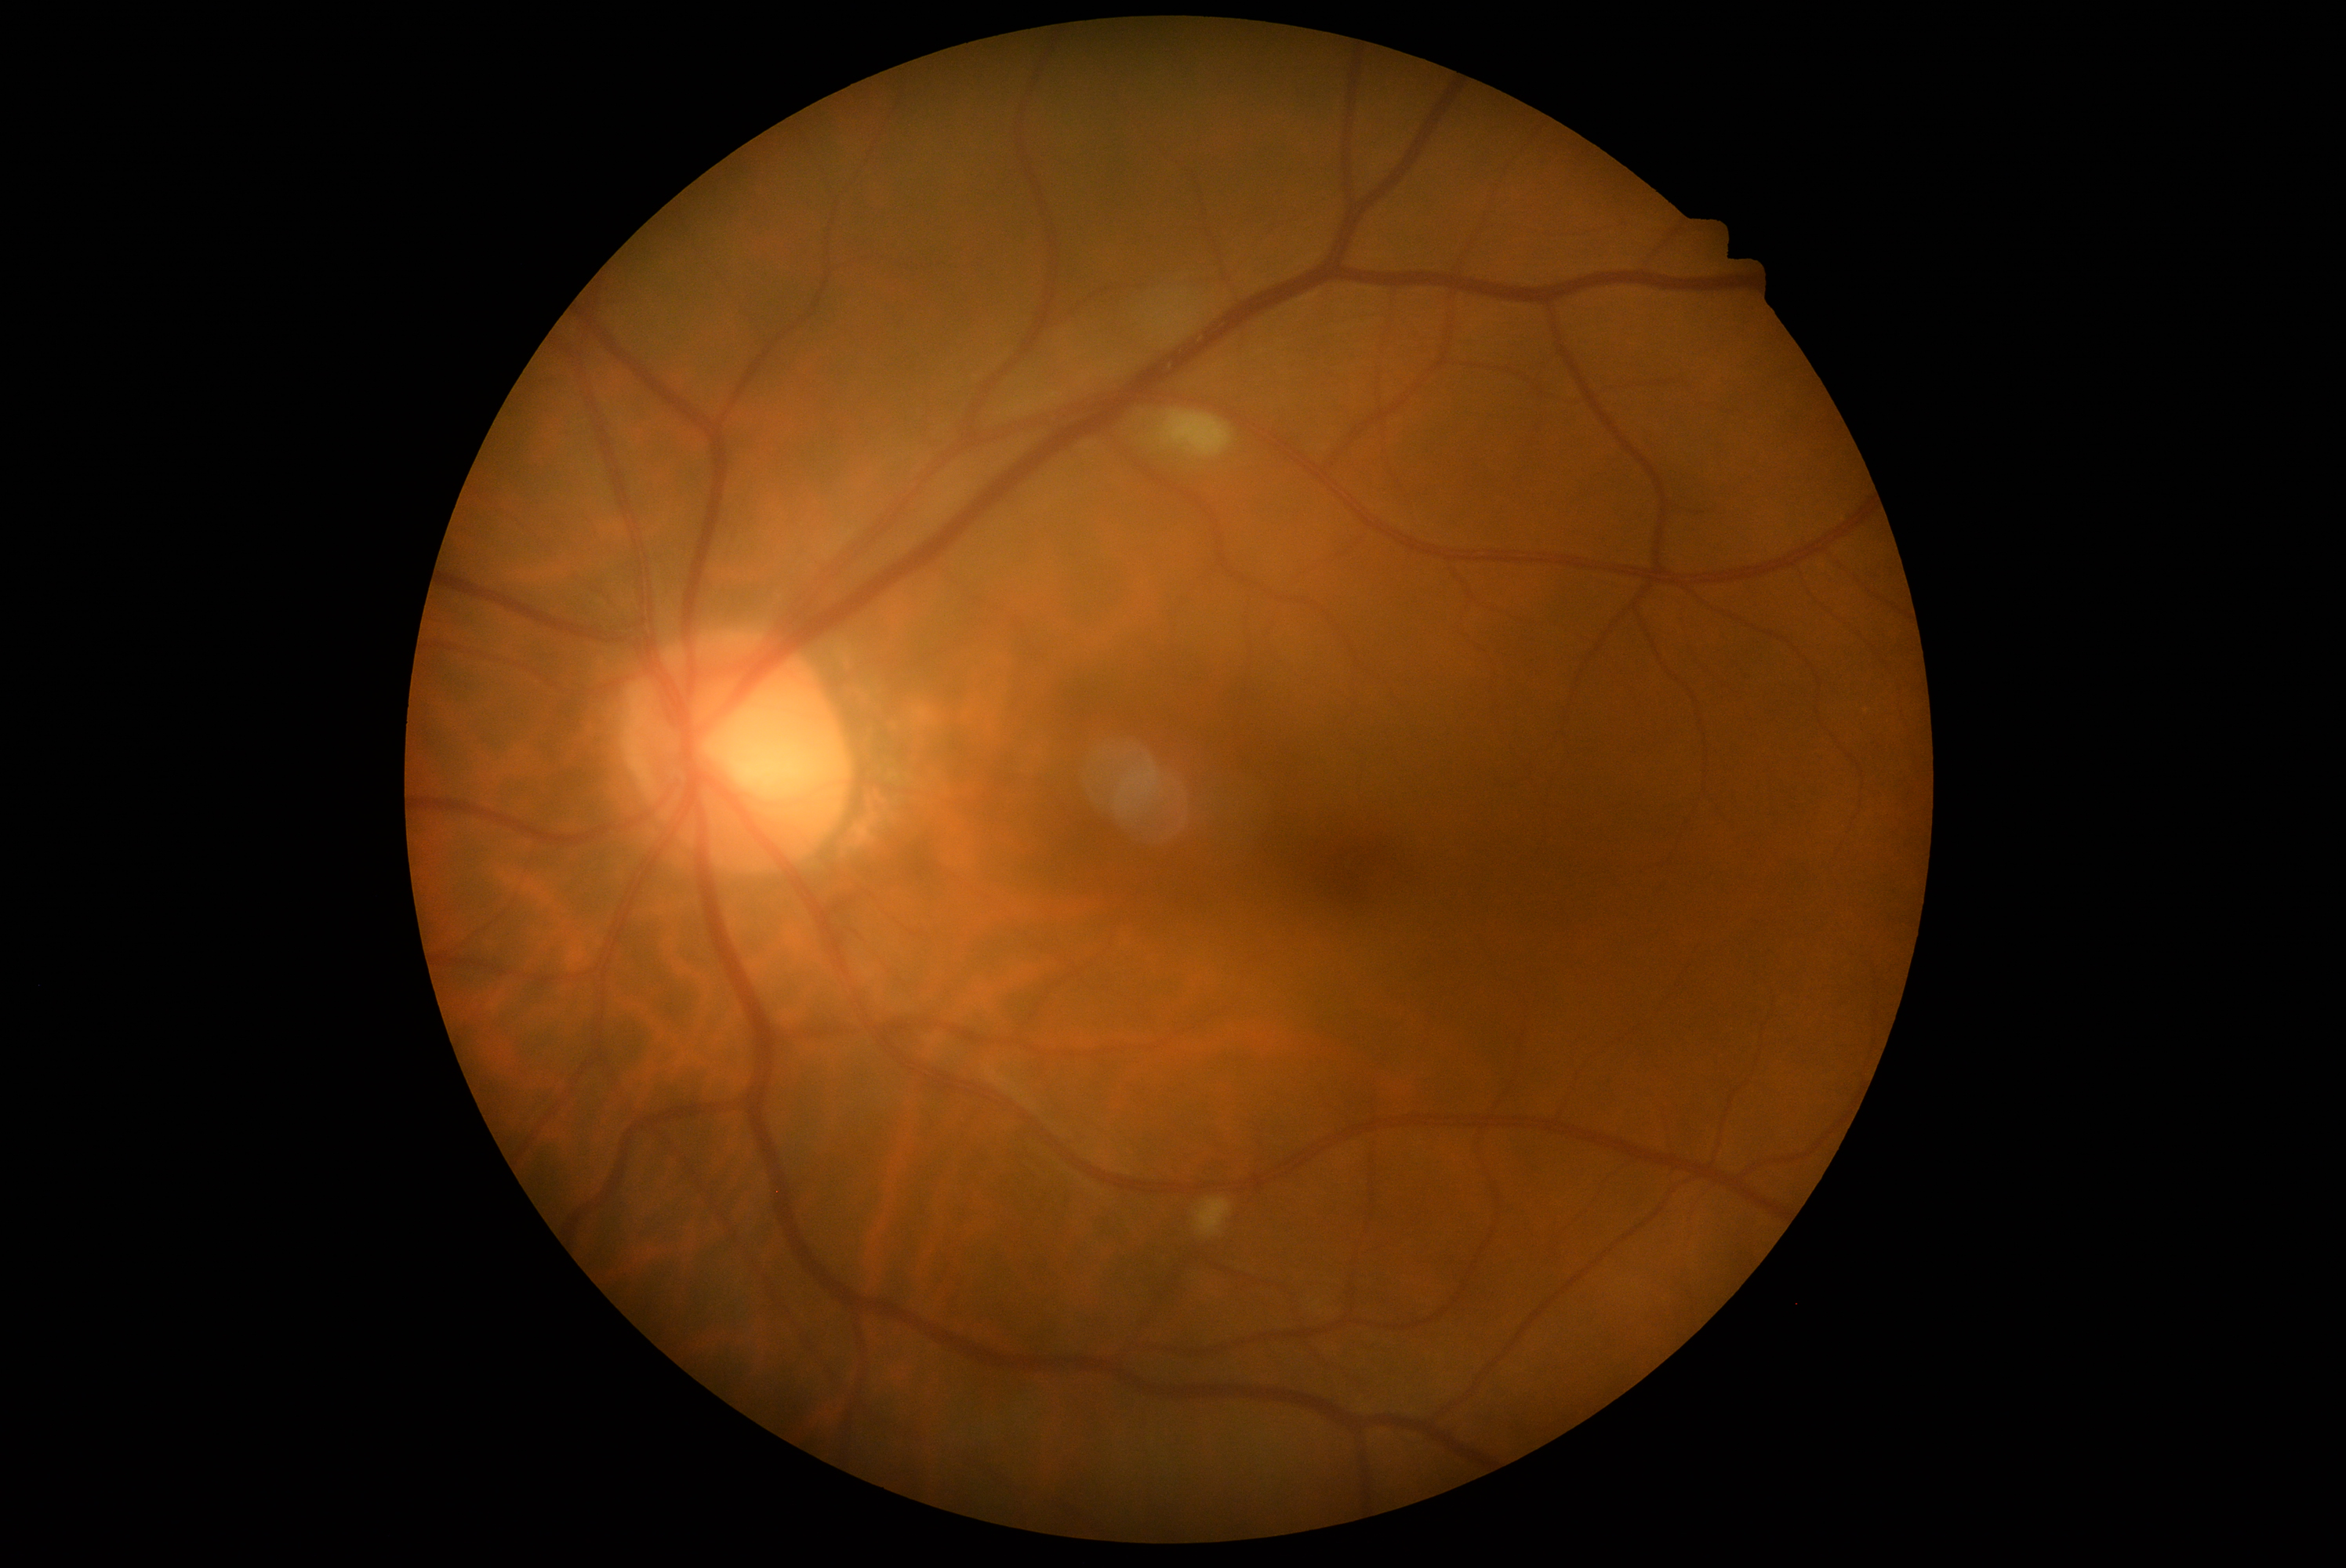
DR is grade 2 (moderate NPDR) — more than just microaneurysms but less than severe NPDR.